1440 by 1080 pixels · wide-field fundus photograph of an infant — 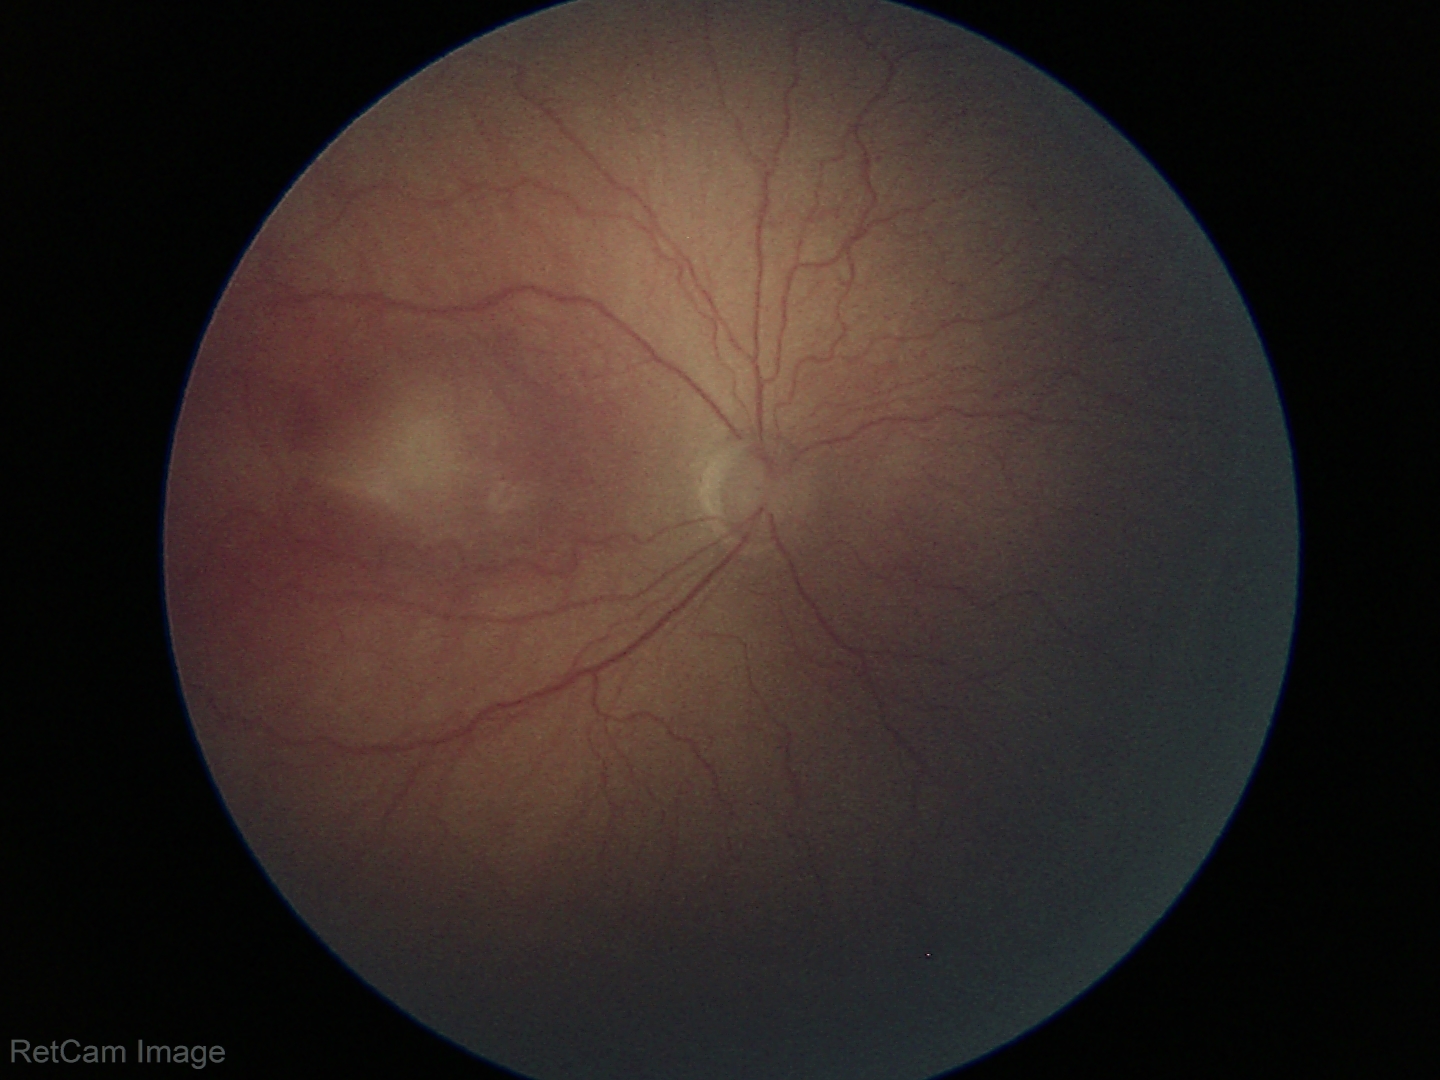

Series diagnosed as ROP stage 2.